Forus 3Nethra Classic fundus camera, 2048x1536, color fundus photograph.
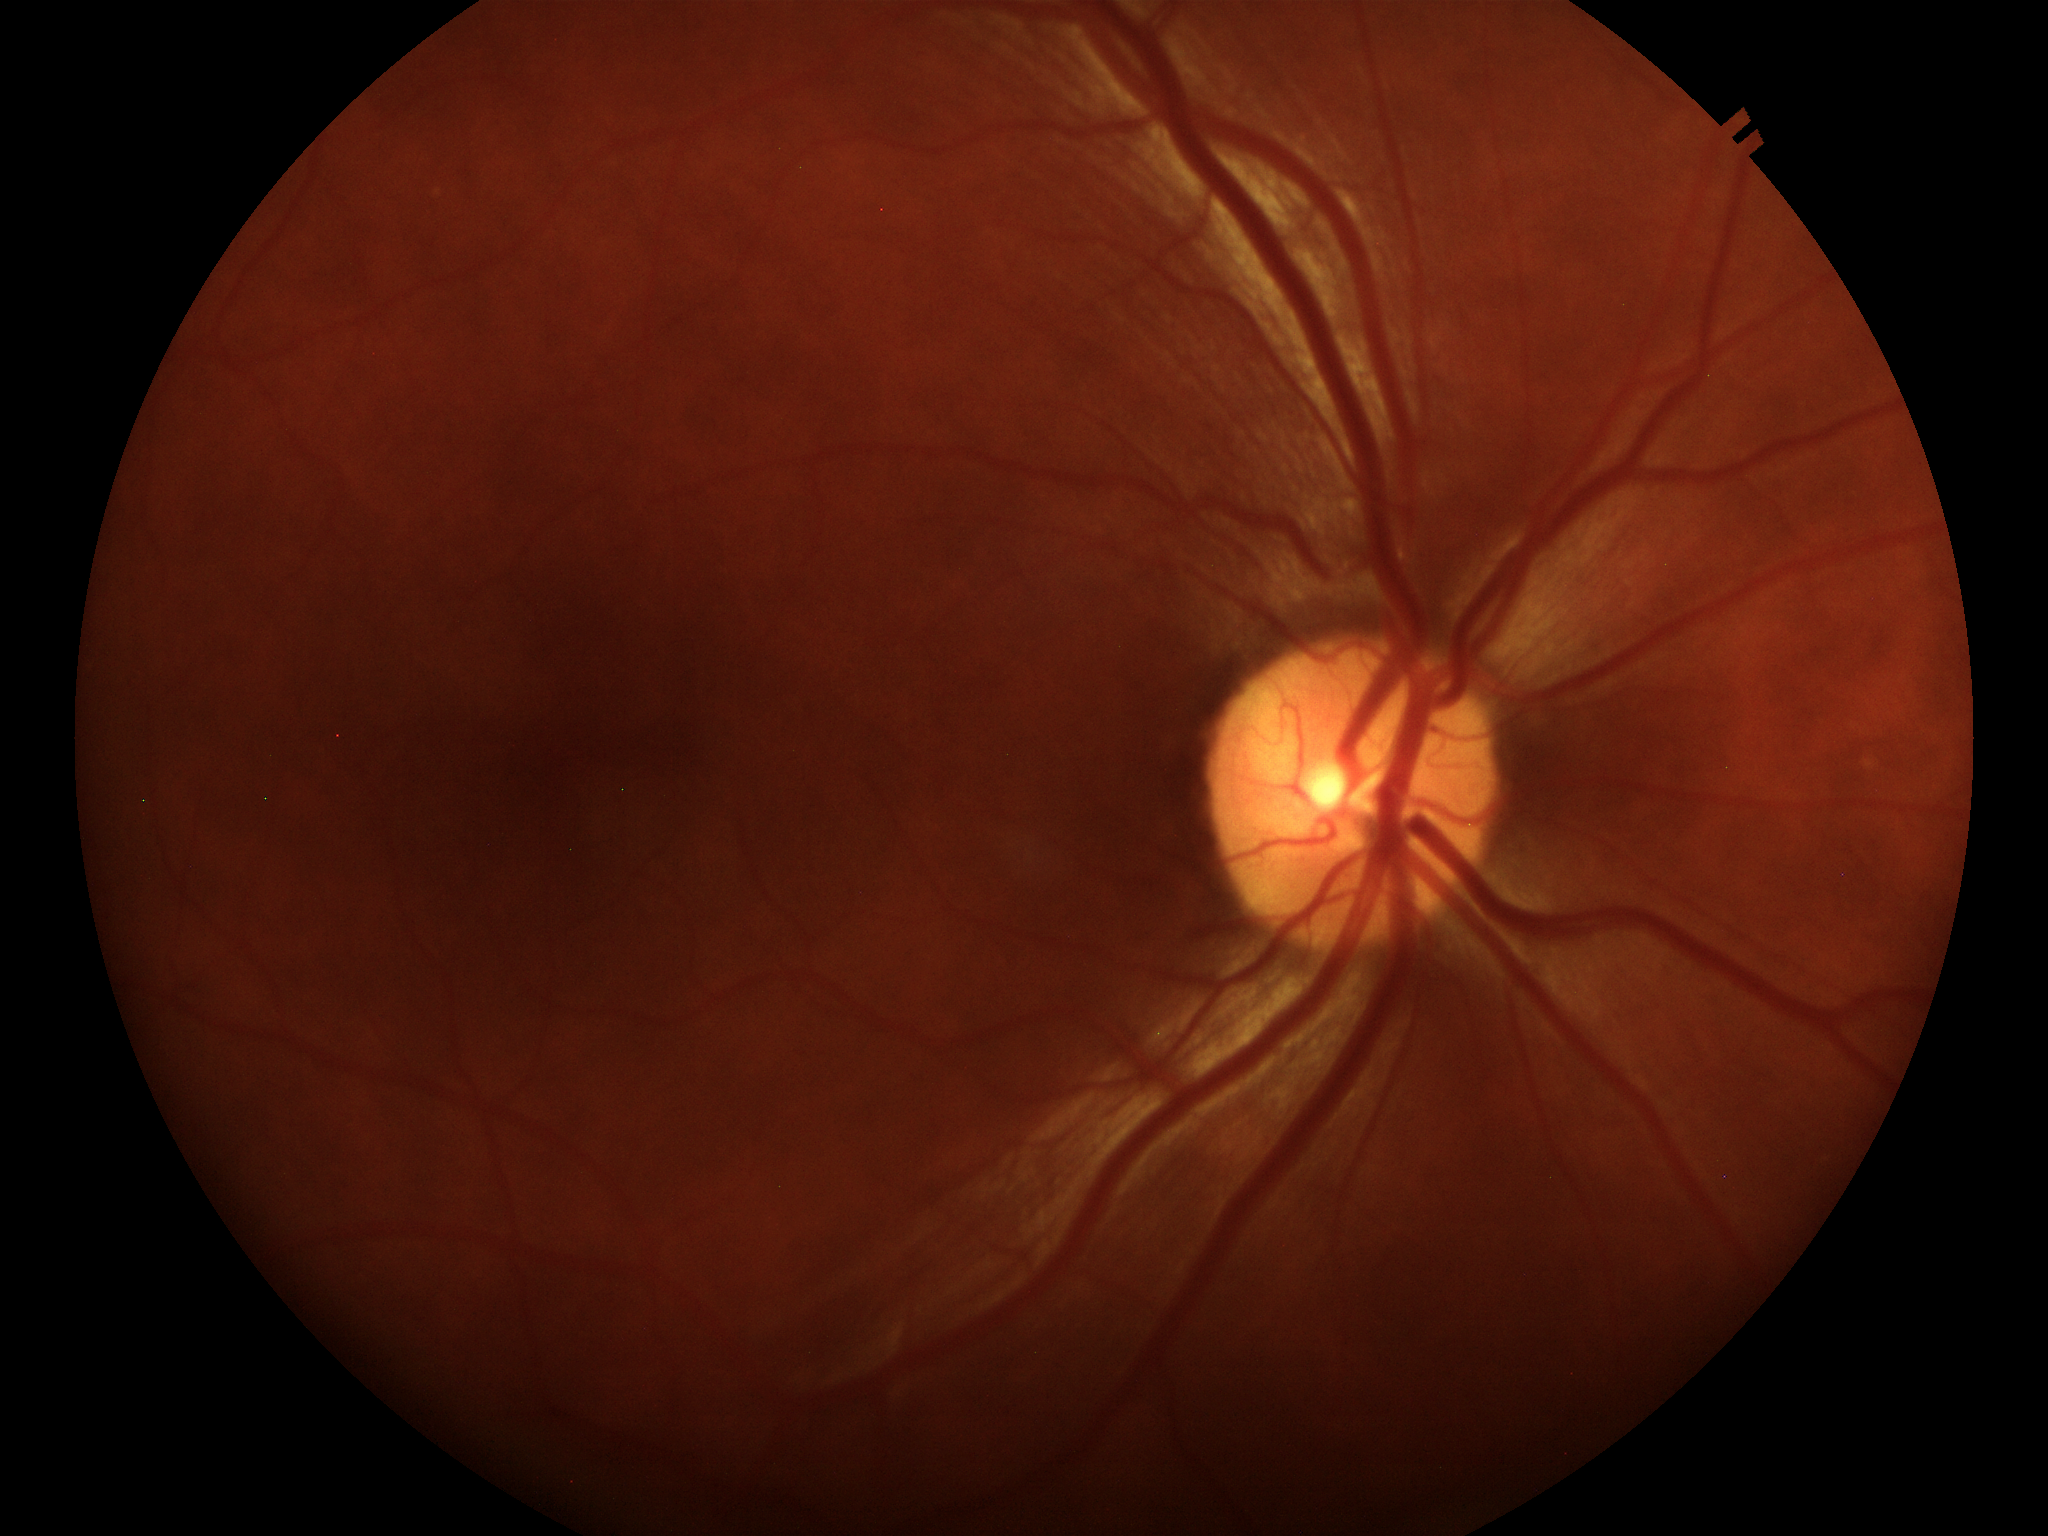 Glaucoma impression = negative
vertical cup-to-disc ratio (VCDR) = 0.42